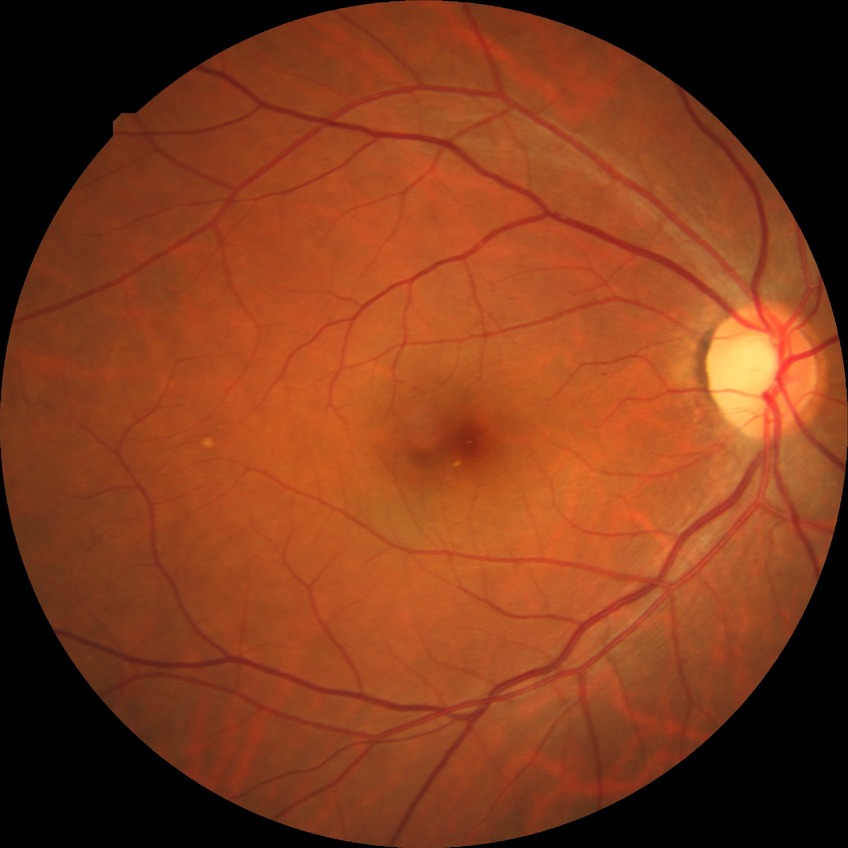

Davis DR grade: SDR.